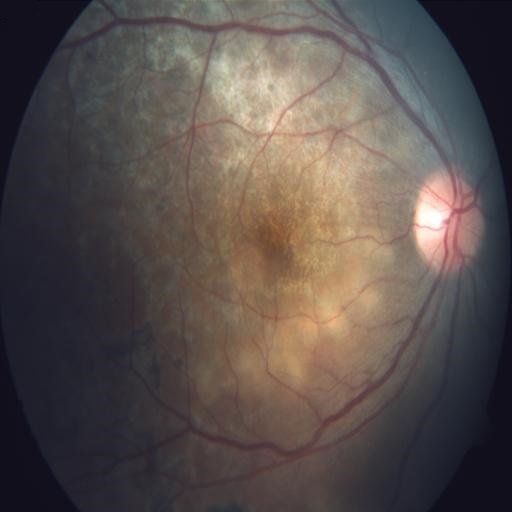

There is evidence of chorioretinitis.